45° field of view. Color fundus image.
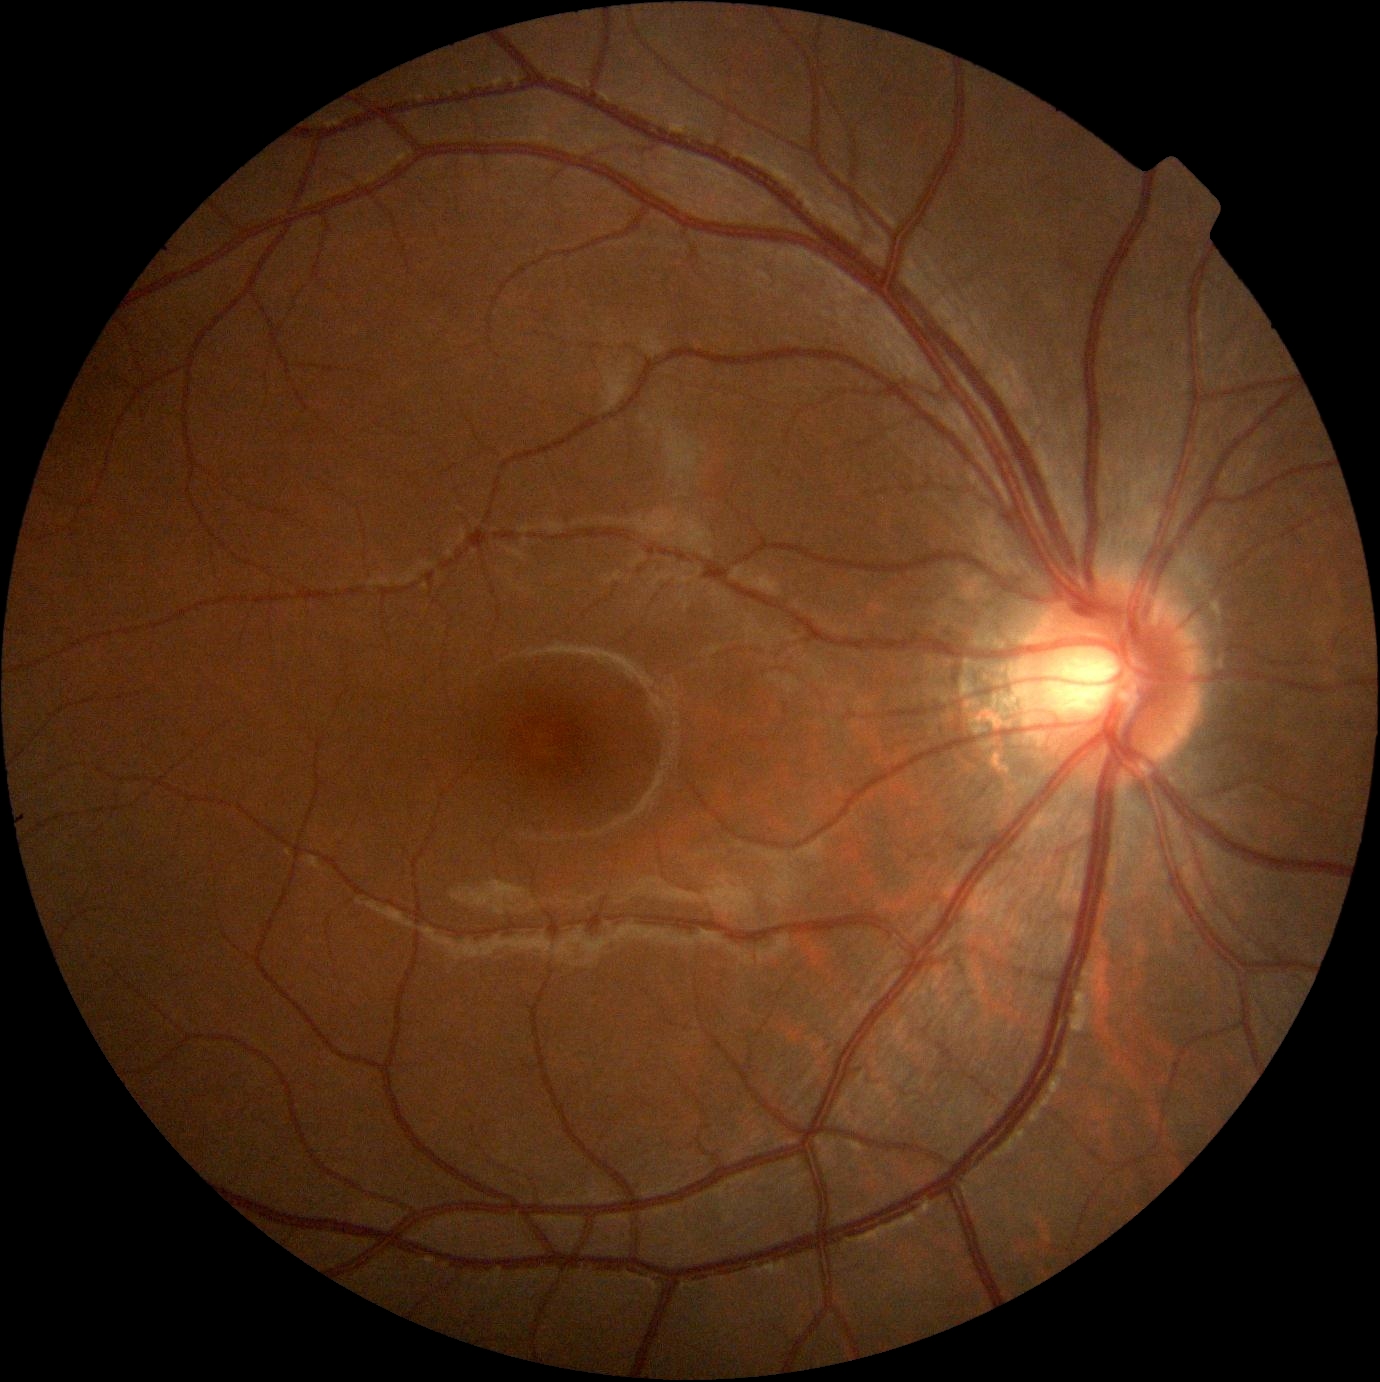 Diabetic retinopathy (DR): no apparent diabetic retinopathy (grade 0).
No diabetic retinal disease findings.